2352 x 1568 pixels.
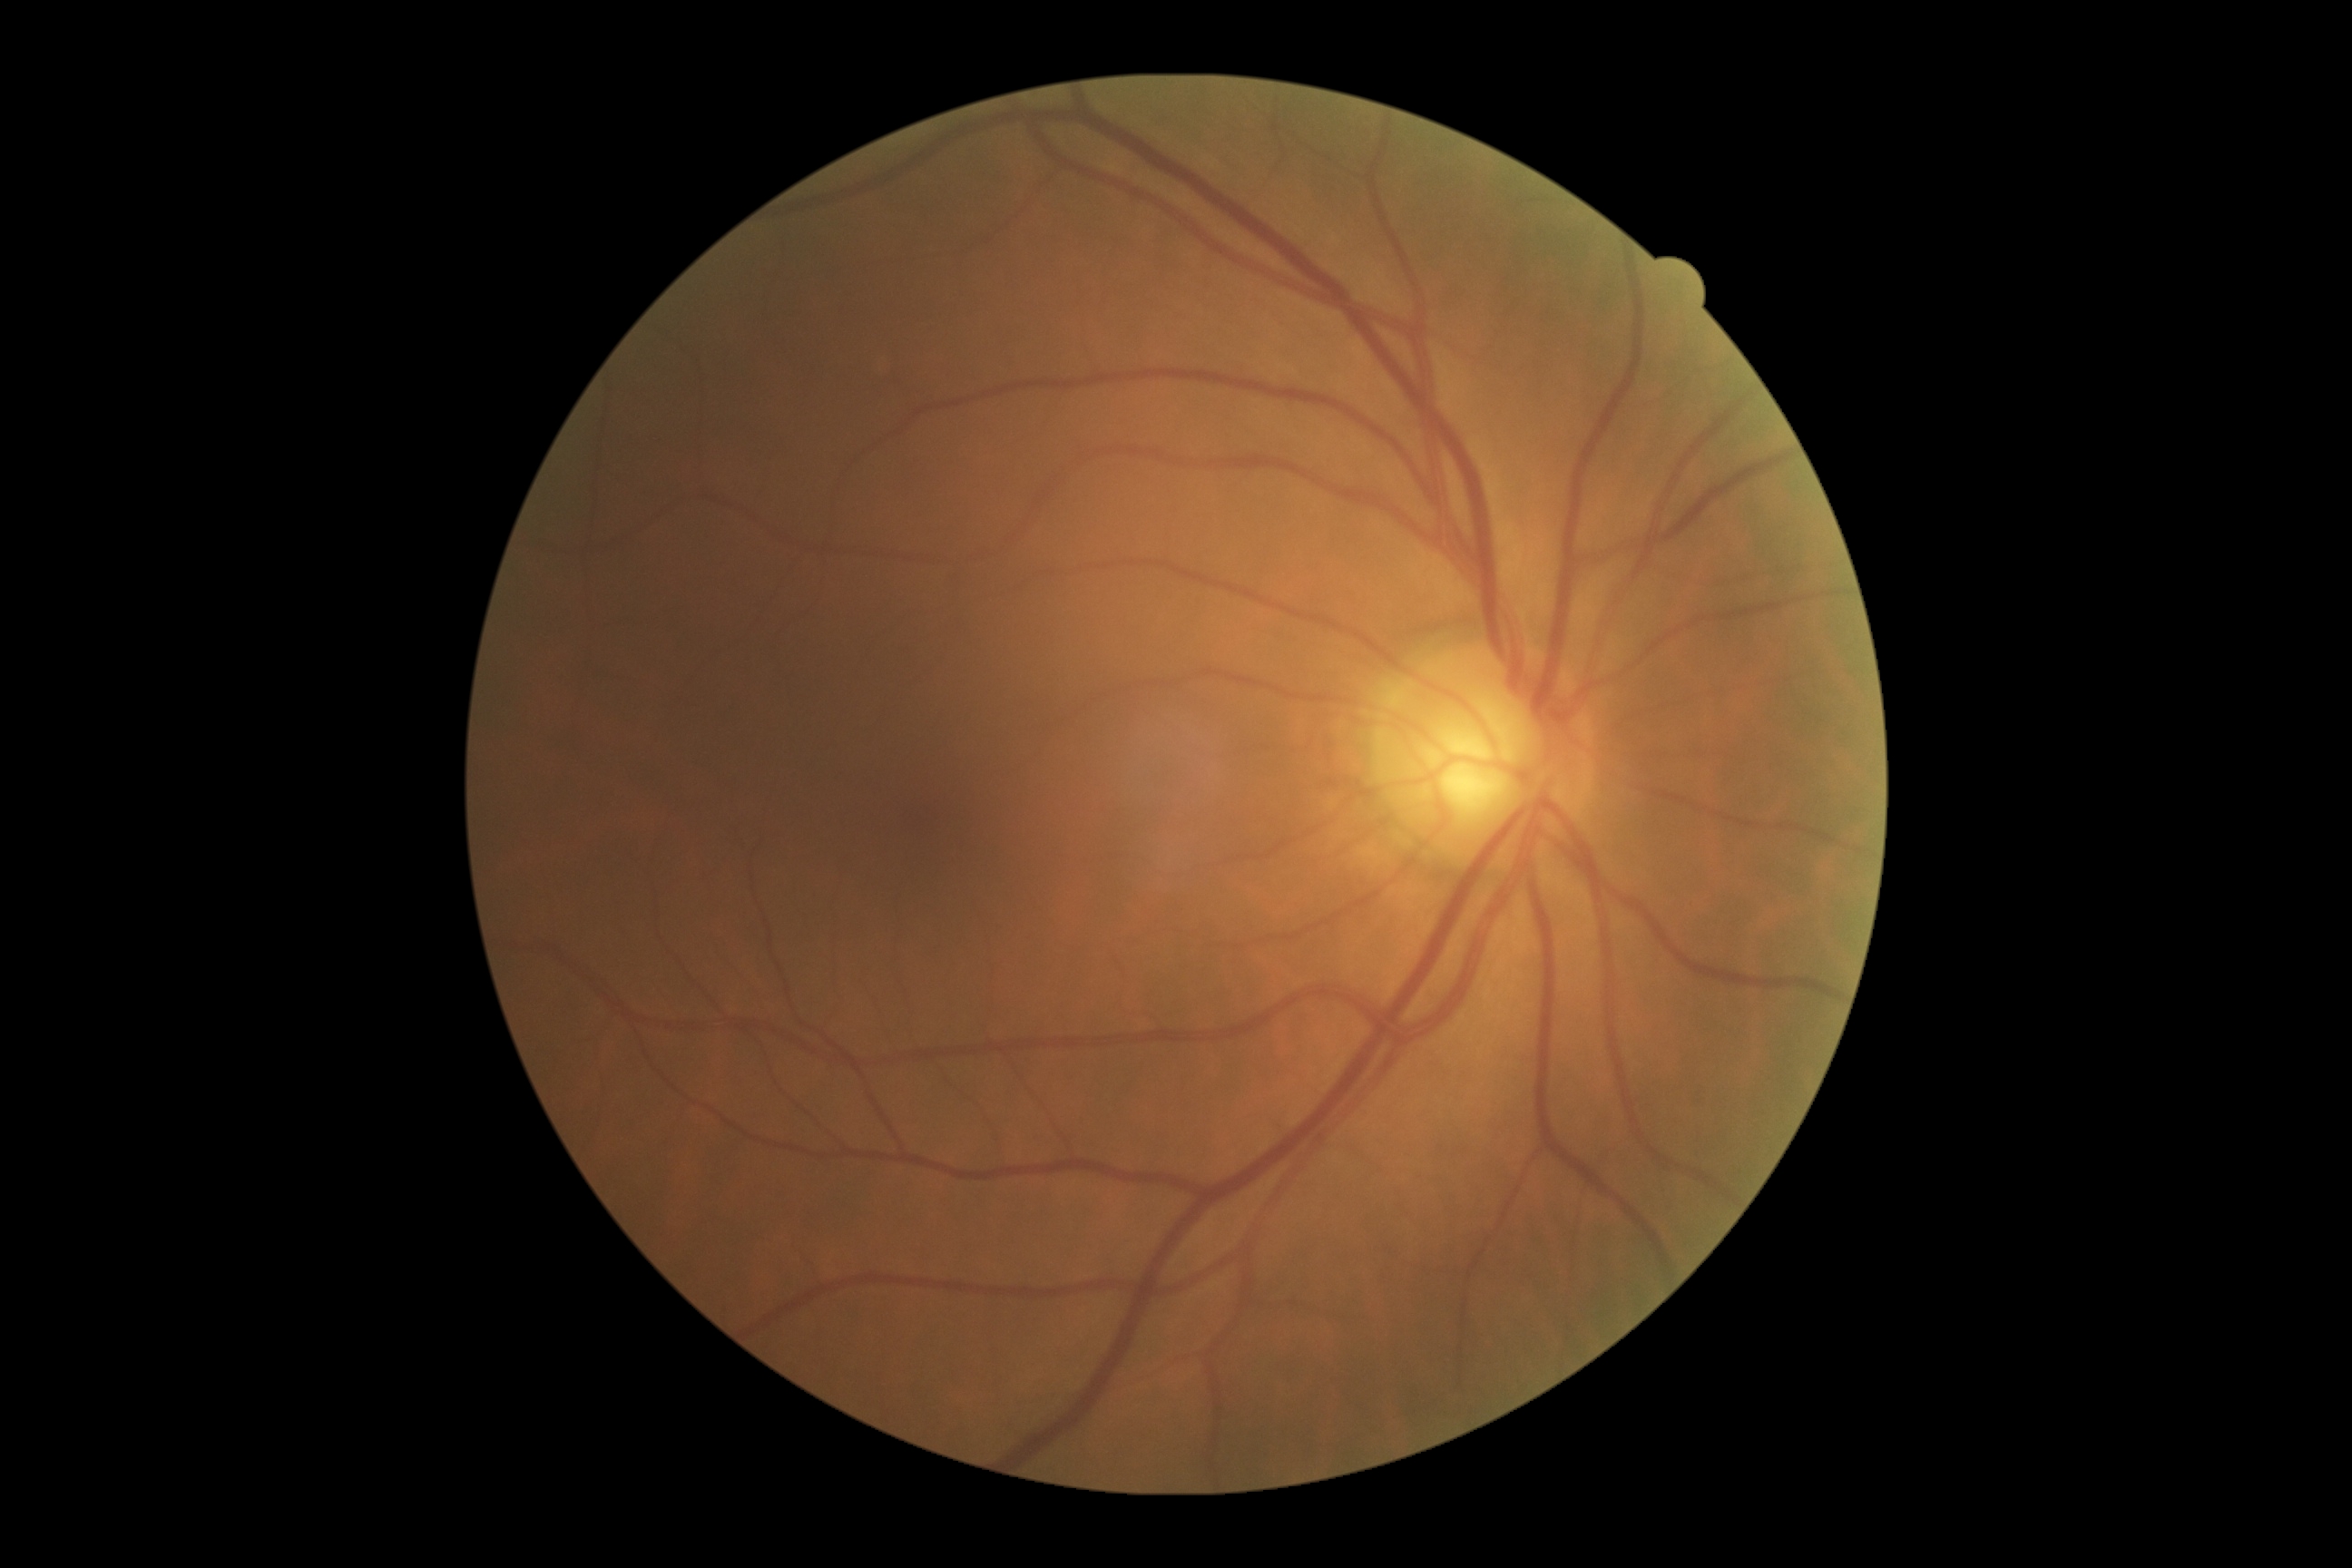

retinopathy grade: no apparent retinopathy (0)
DR impression: no signs of DR